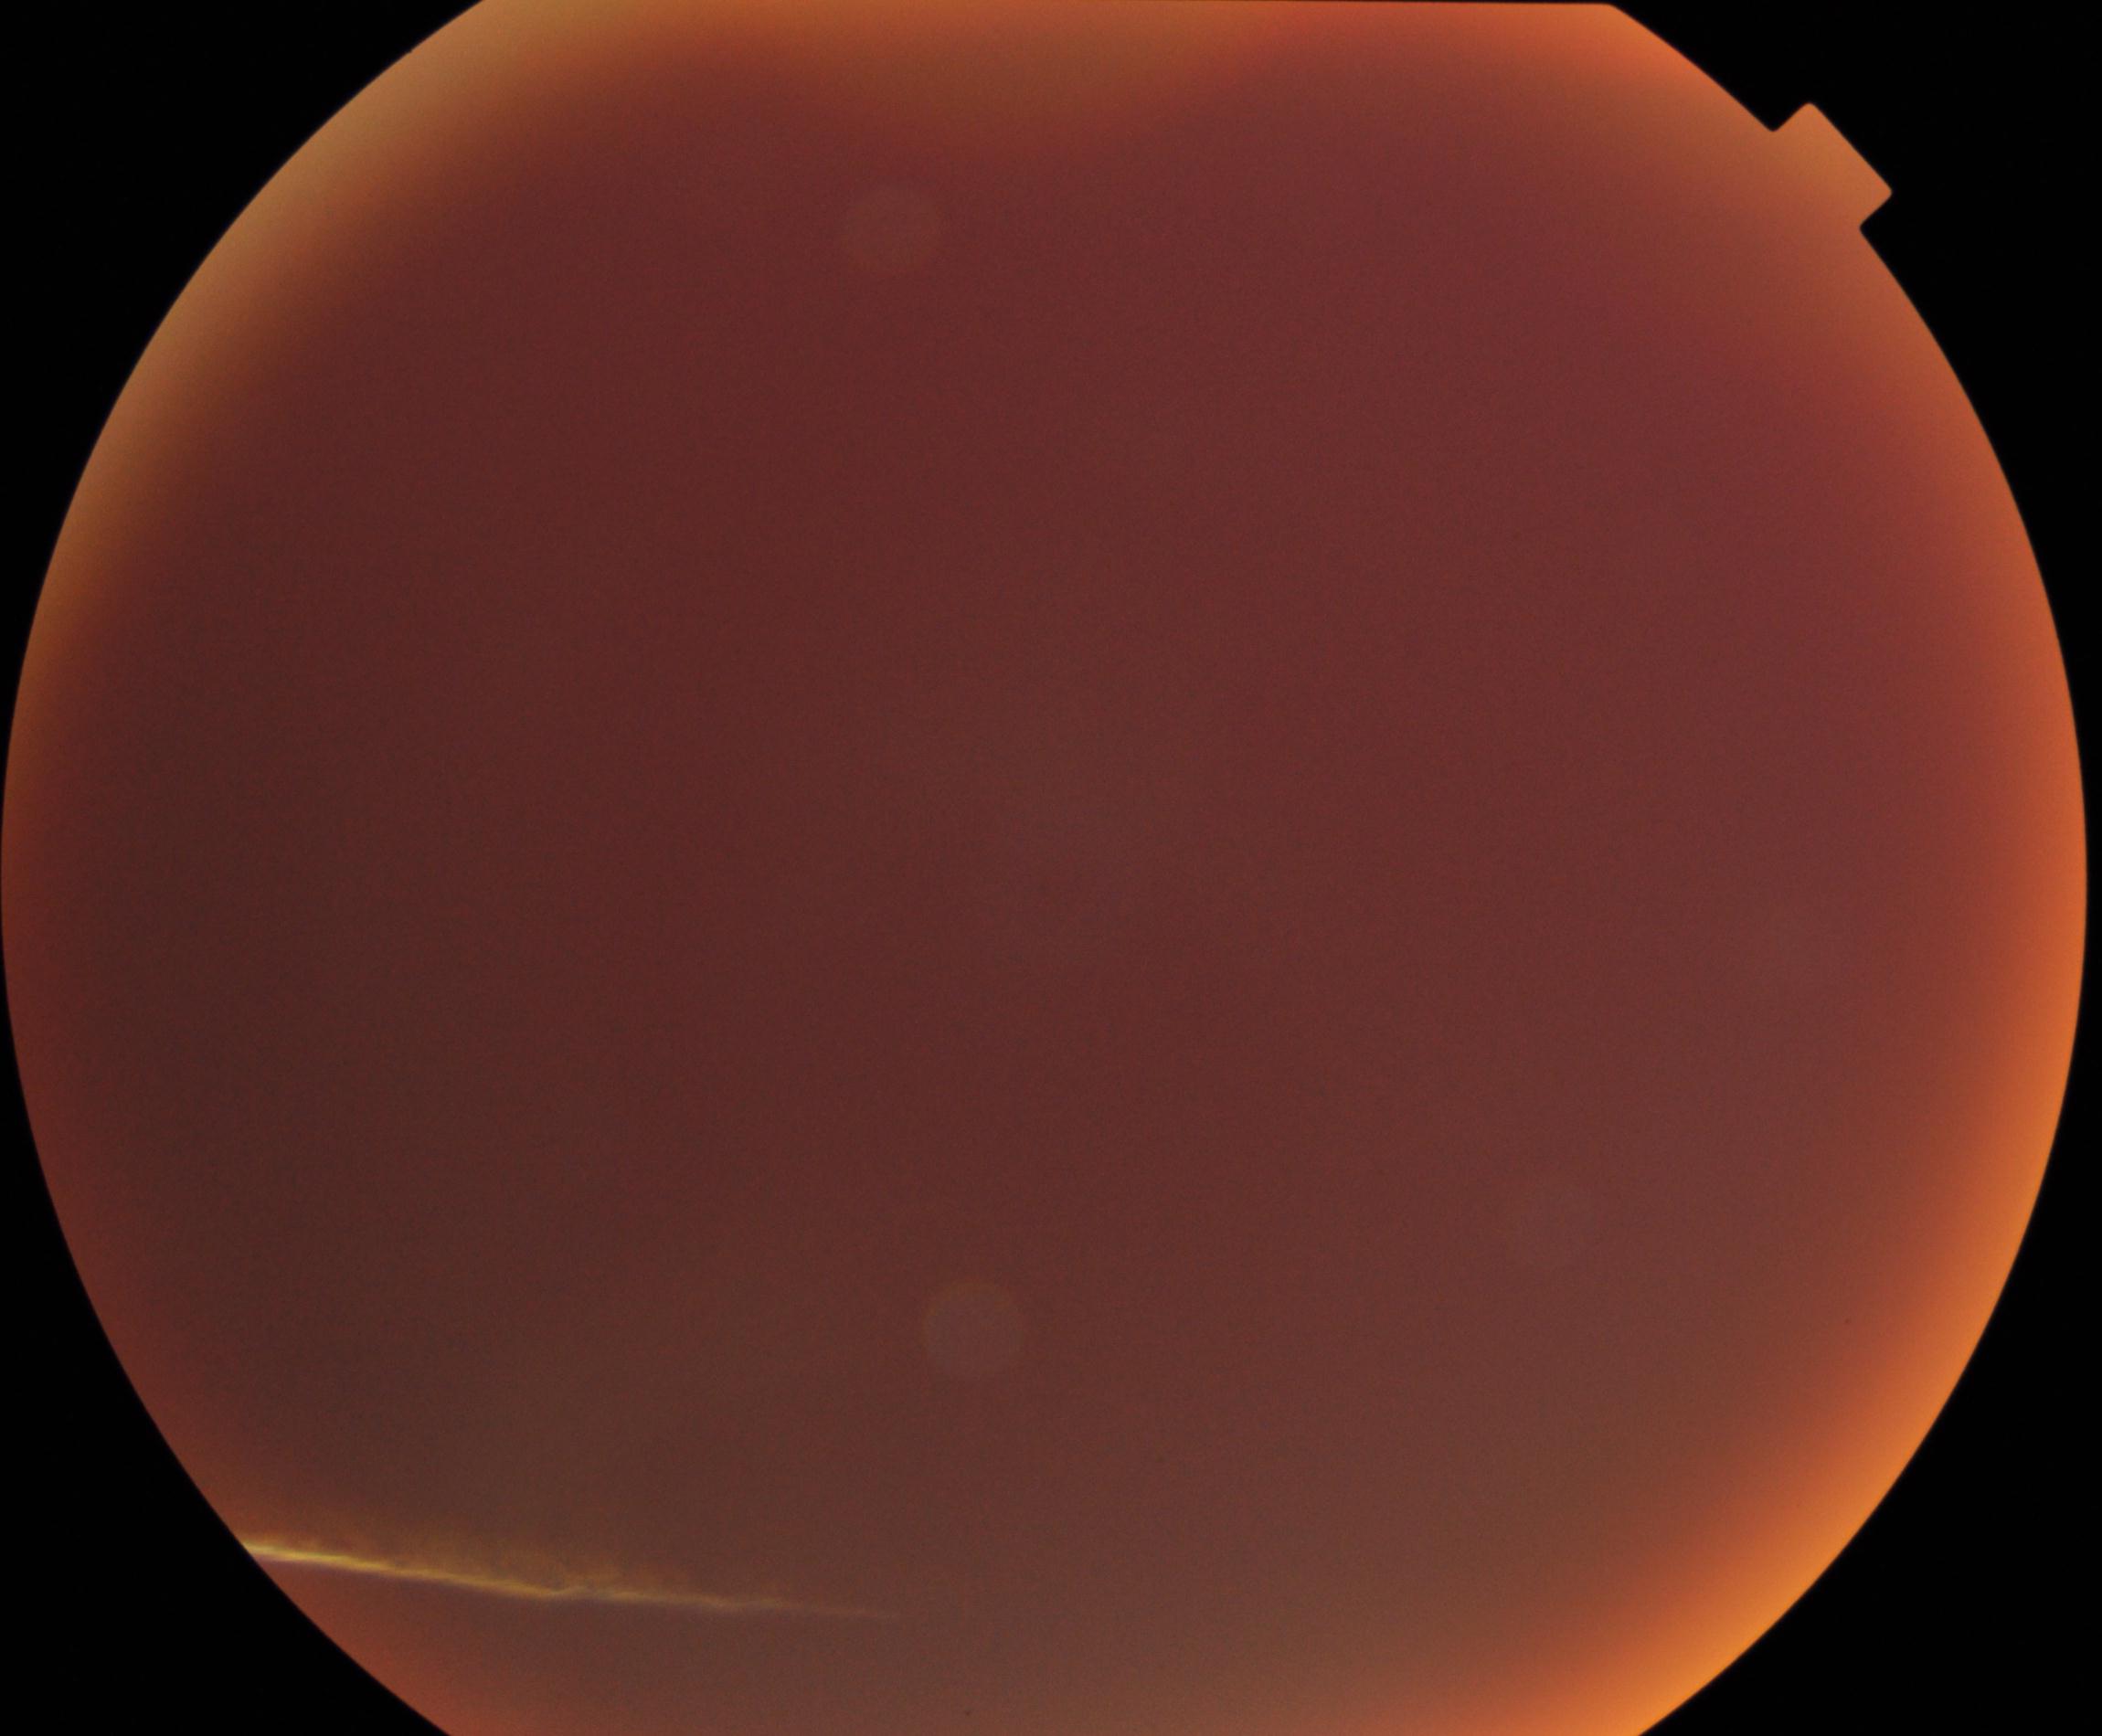

Gradability: poor, substantial obscuration of retinal landmarks. Proliferative retinopathy: not identified.